45 degree fundus photograph · modified Davis classification.
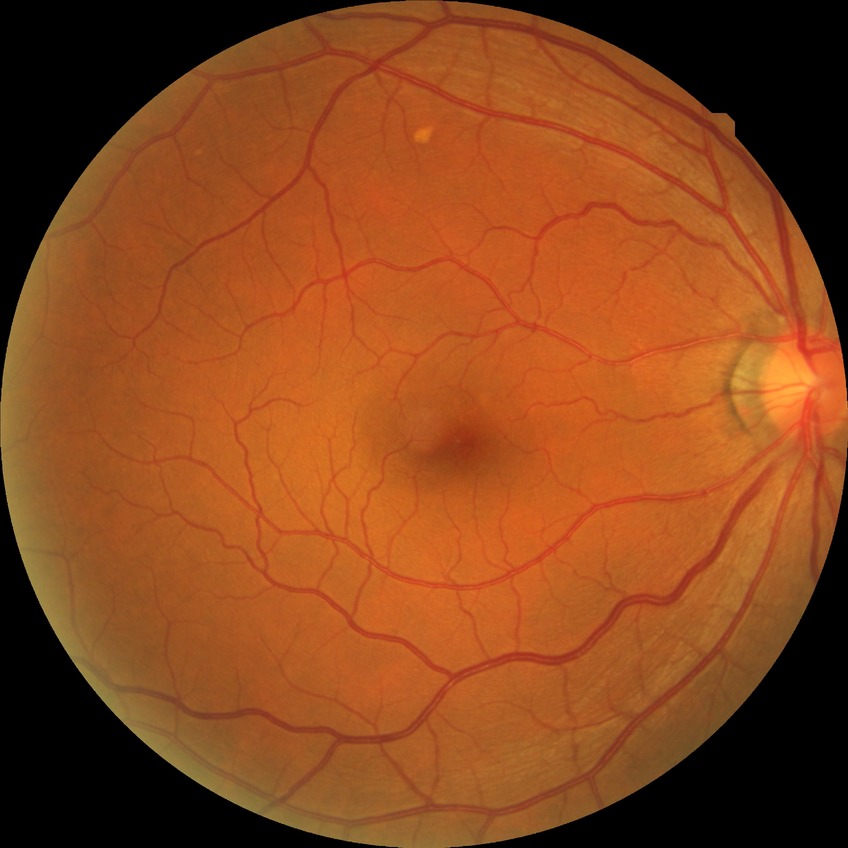
Diabetic retinopathy stage is no diabetic retinopathy.